RetCam wide-field infant fundus image
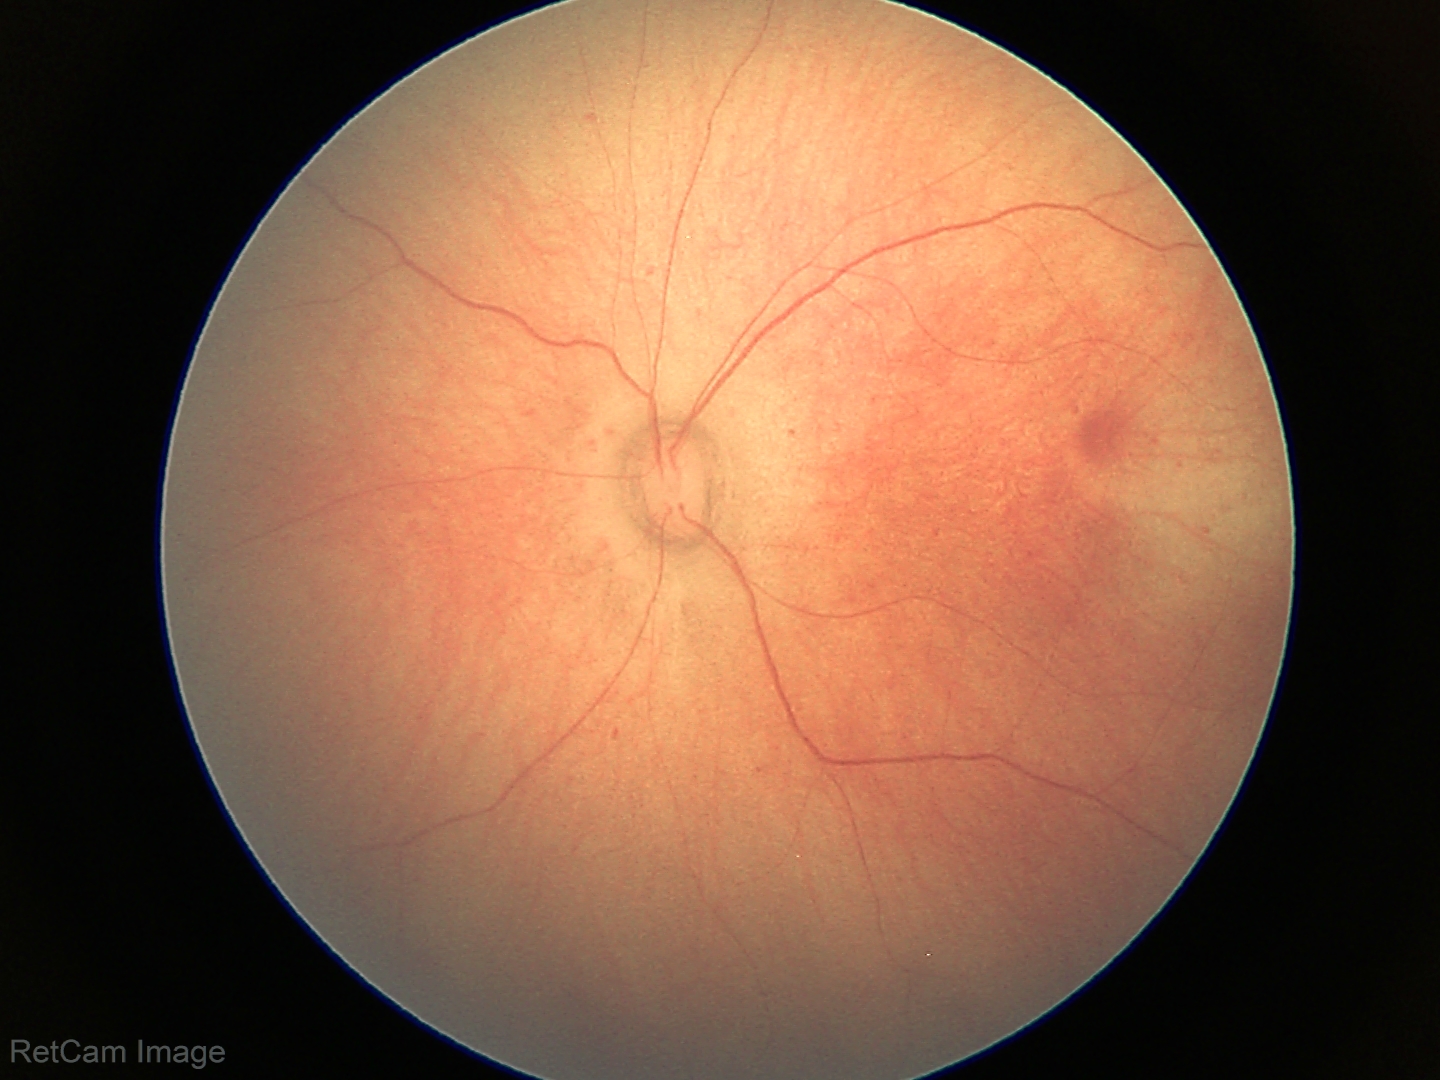

Screening diagnosis: normal fundus examination.